Davis DR grading:
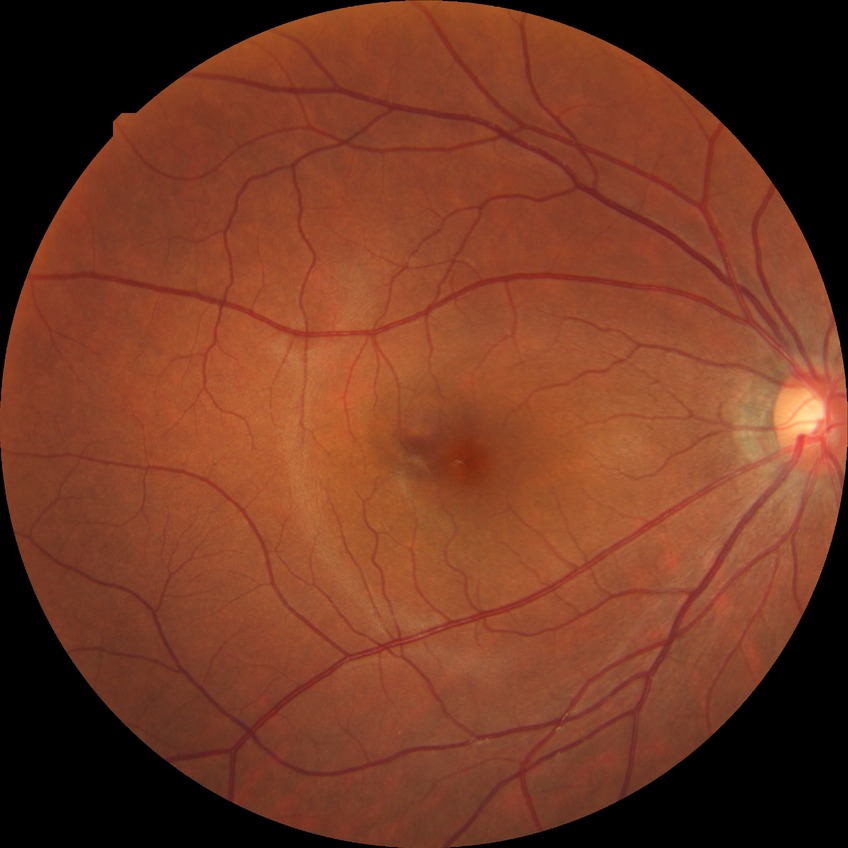
{"davis_grade": "NDR (no diabetic retinopathy)"}